Acquired with a NIDEK AFC-230, modified Davis grading — 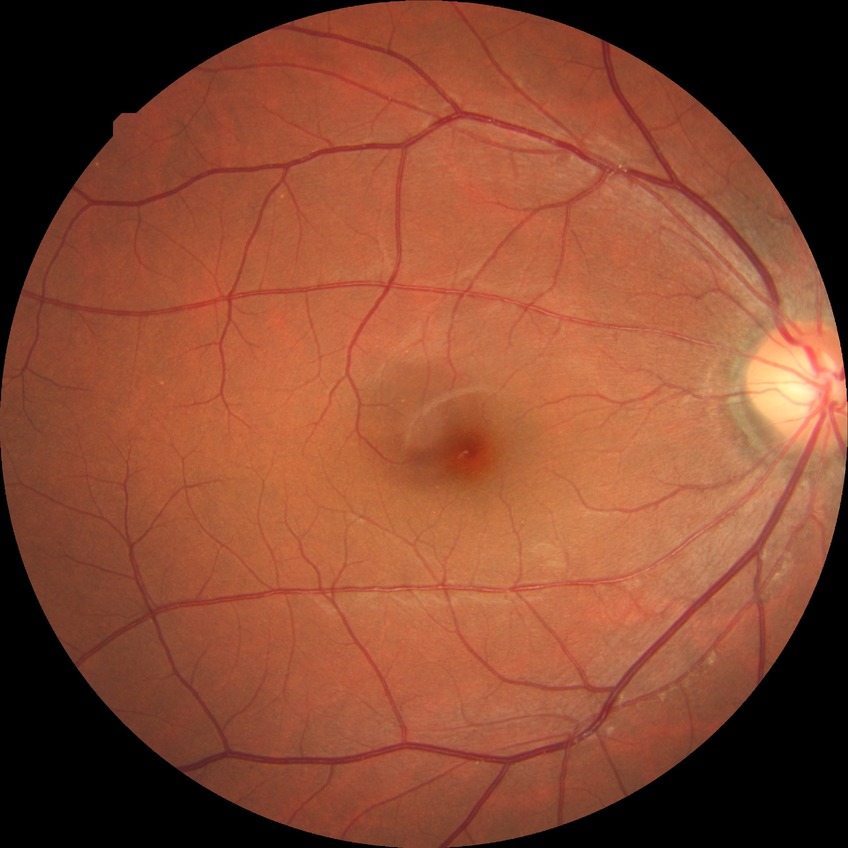

Modified Davis classification: no diabetic retinopathy.